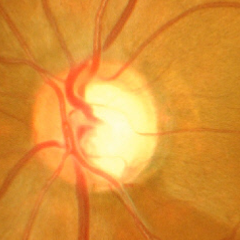
Findings consistent with advanced glaucomatous optic neuropathy.